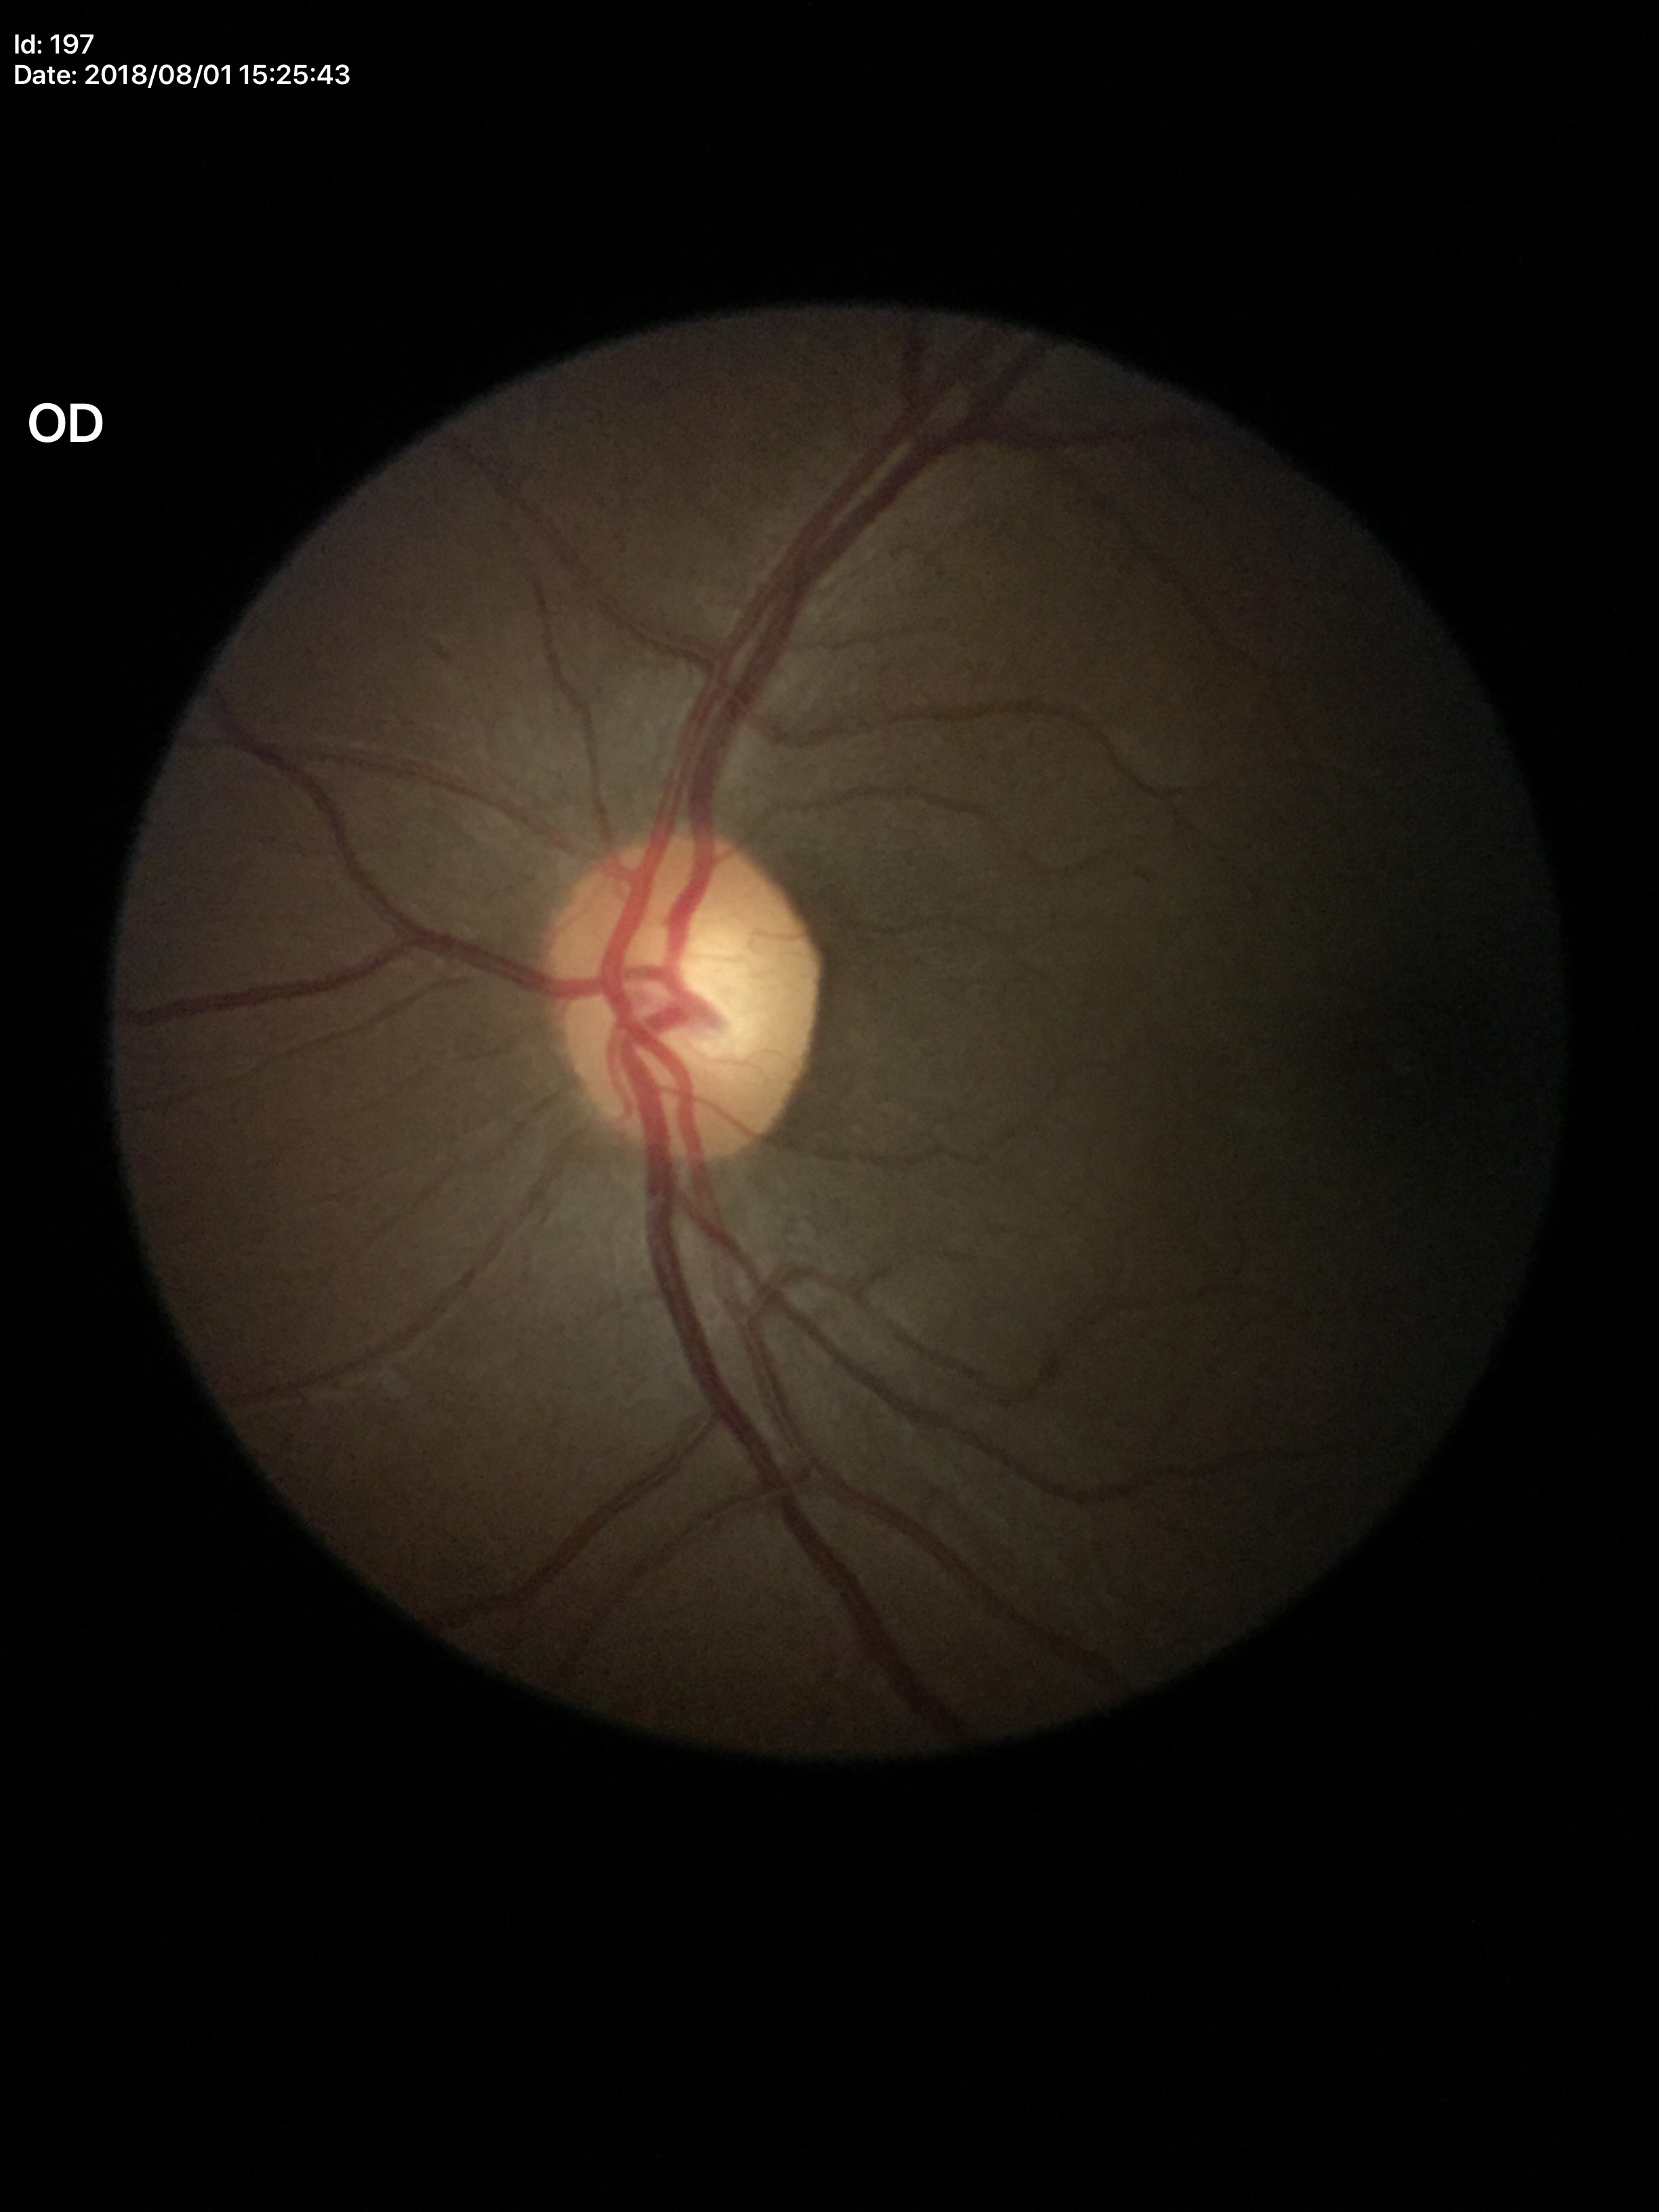 VCDR of 0.58.
Glaucoma decision: no suspicious findings.